Infant wide-field retinal image; captured with the Phoenix ICON (100° field of view); 1240x1240px:
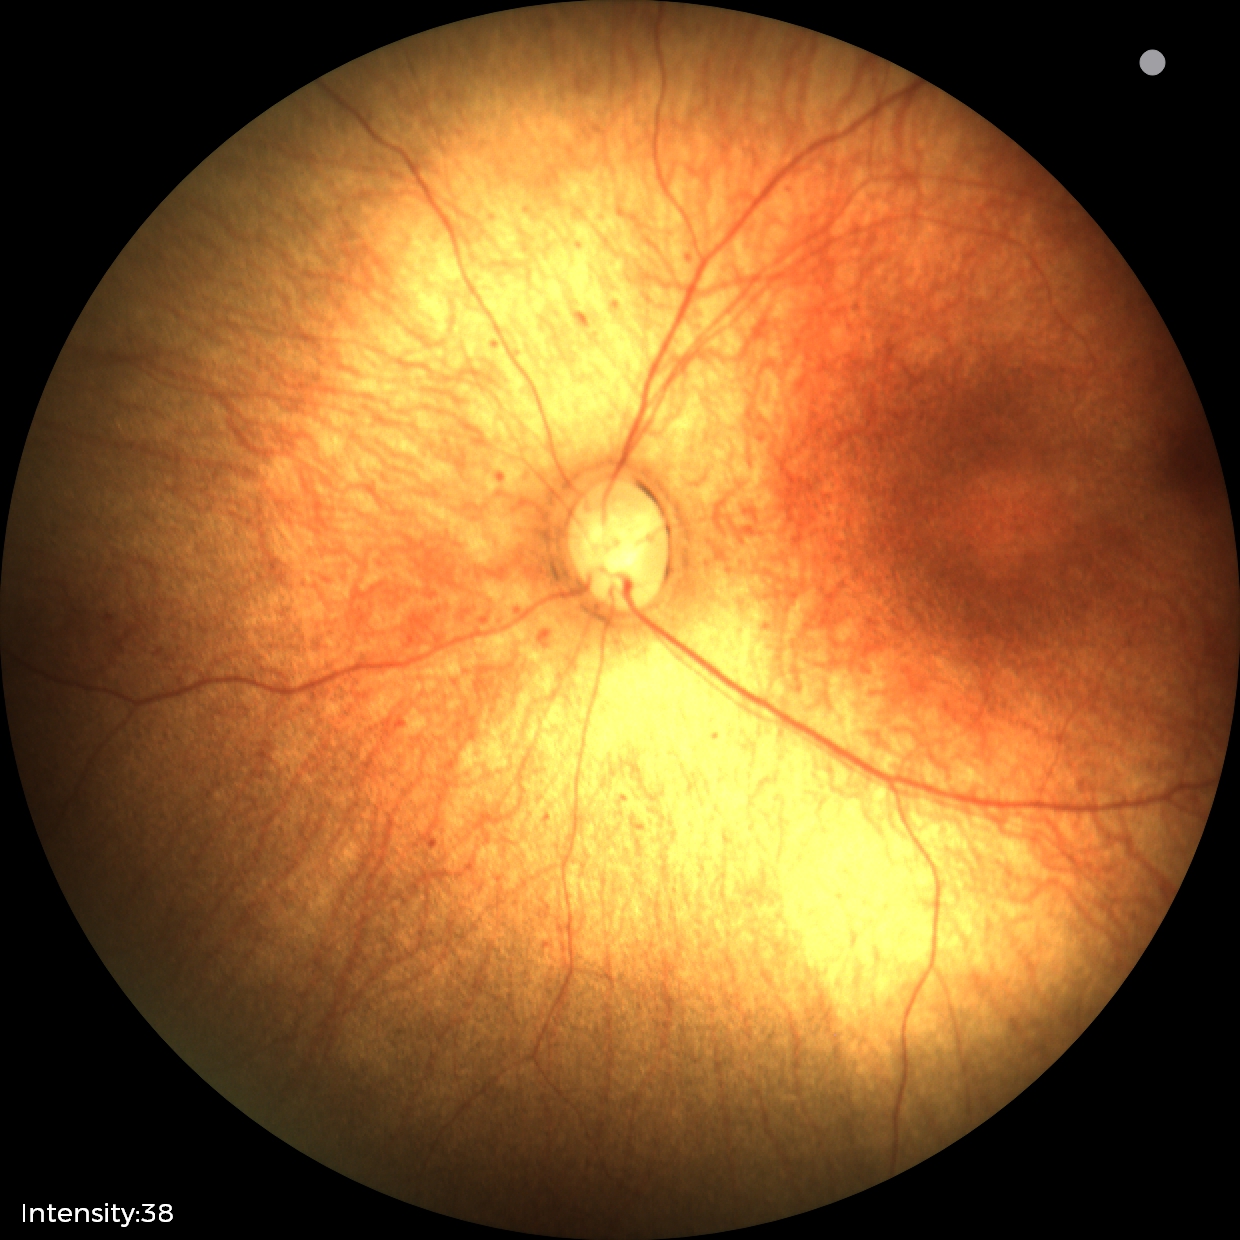

Examination with physiological retinal findings.